Color fundus photograph — 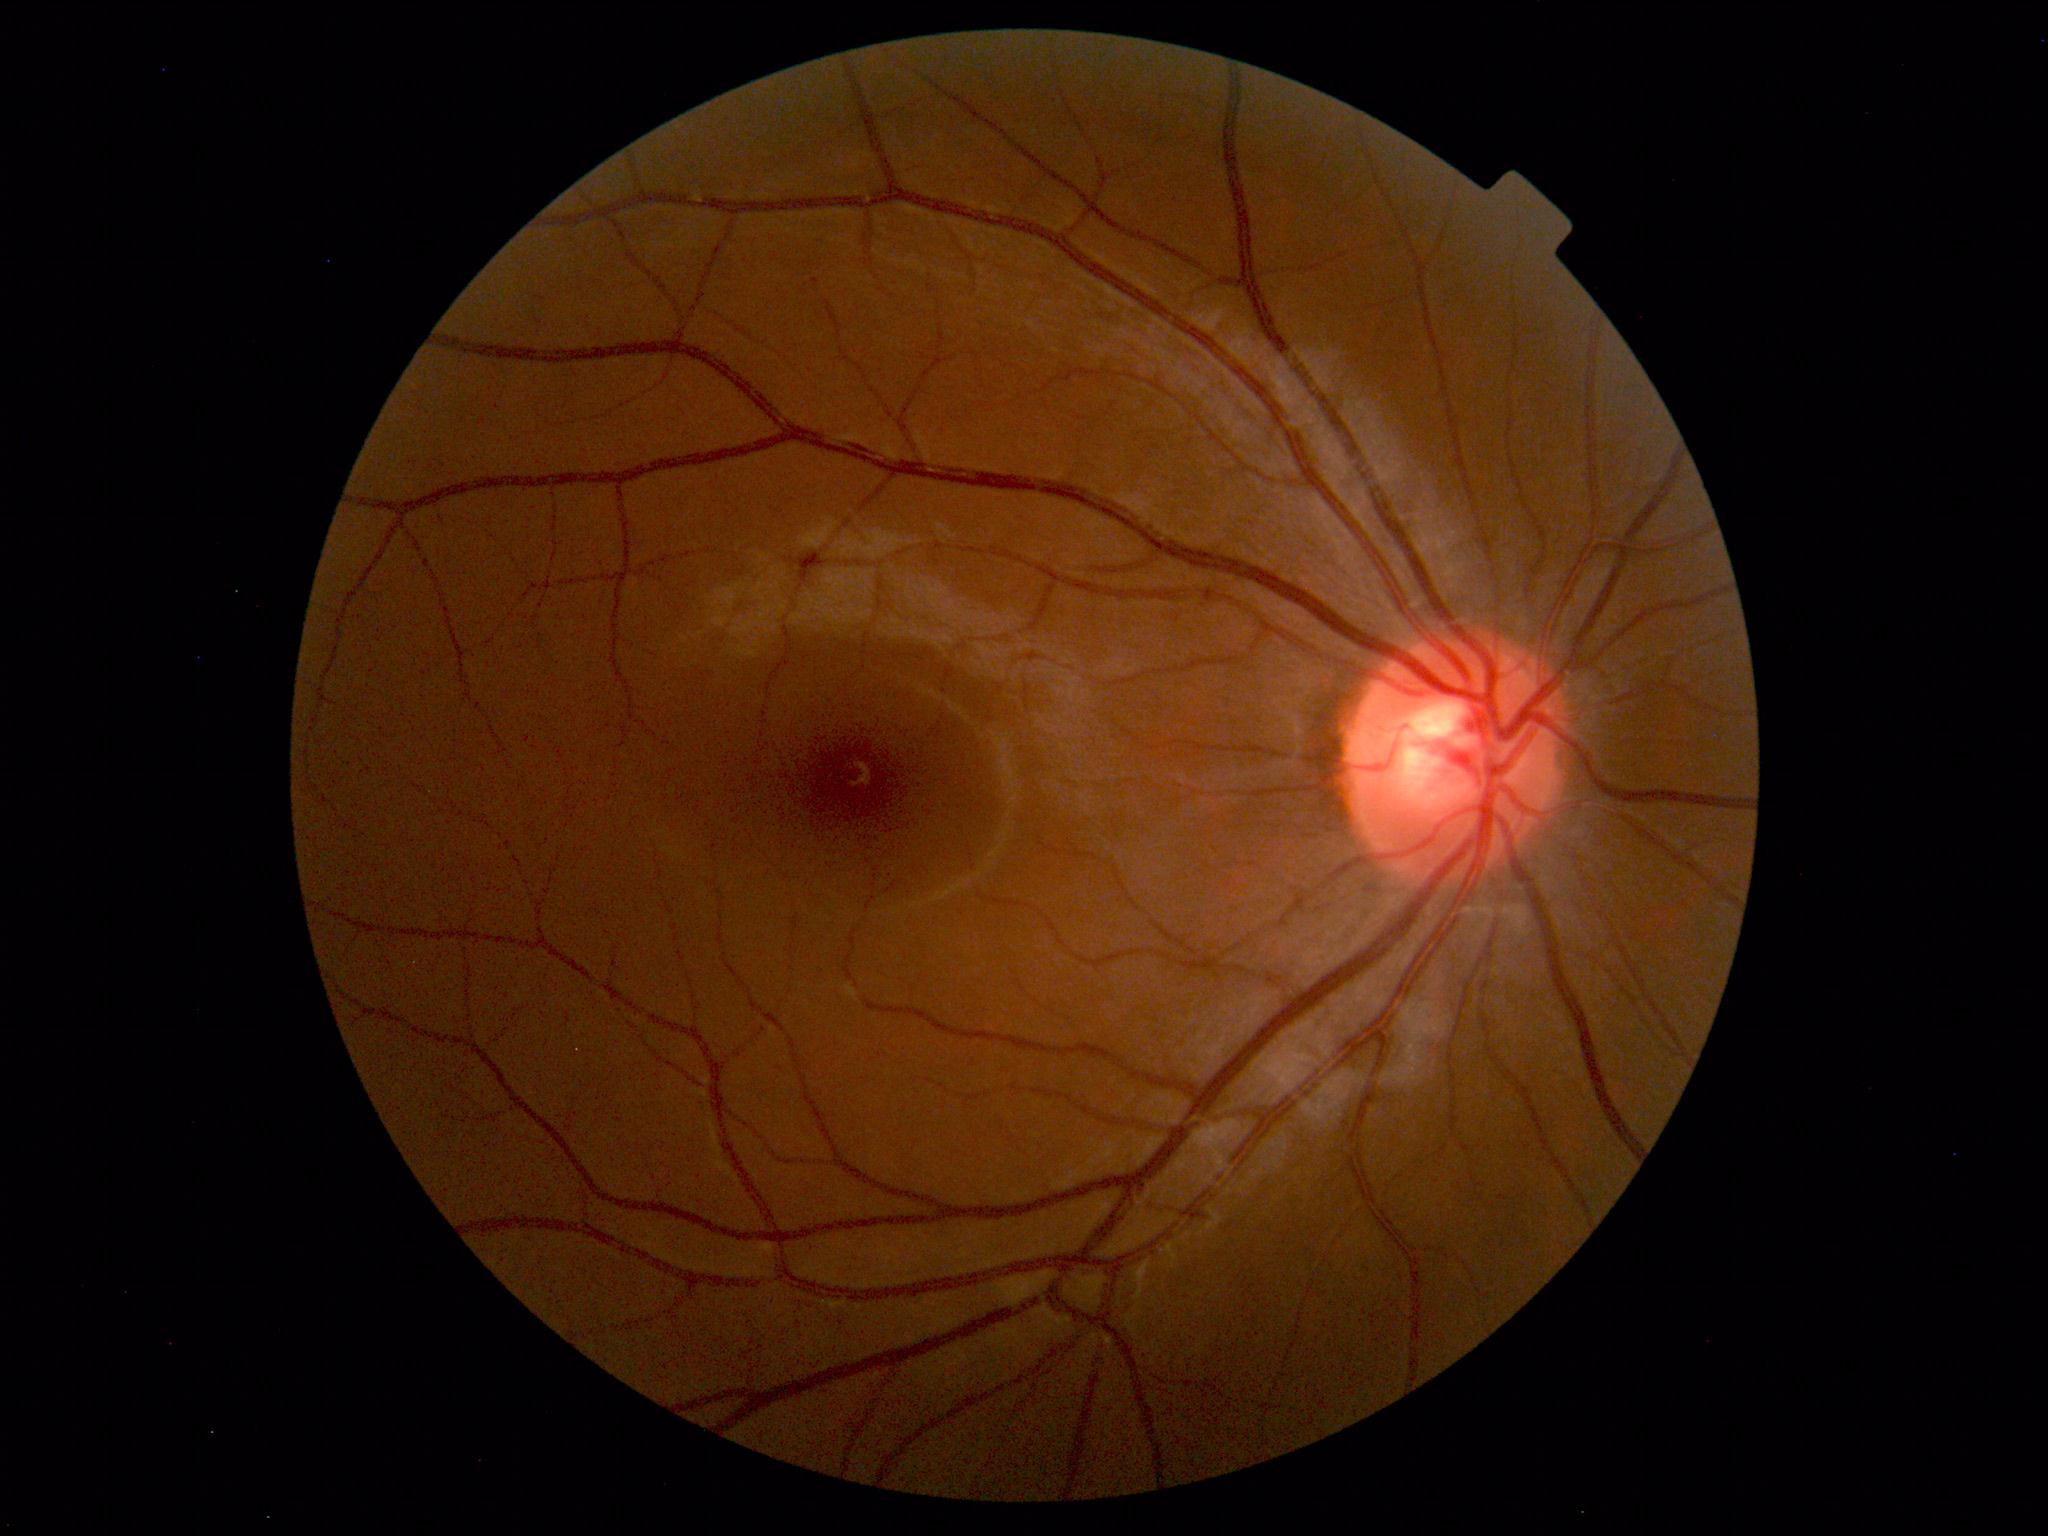
No abnormal findings on fundus examination.